Graded on the modified Davis scale
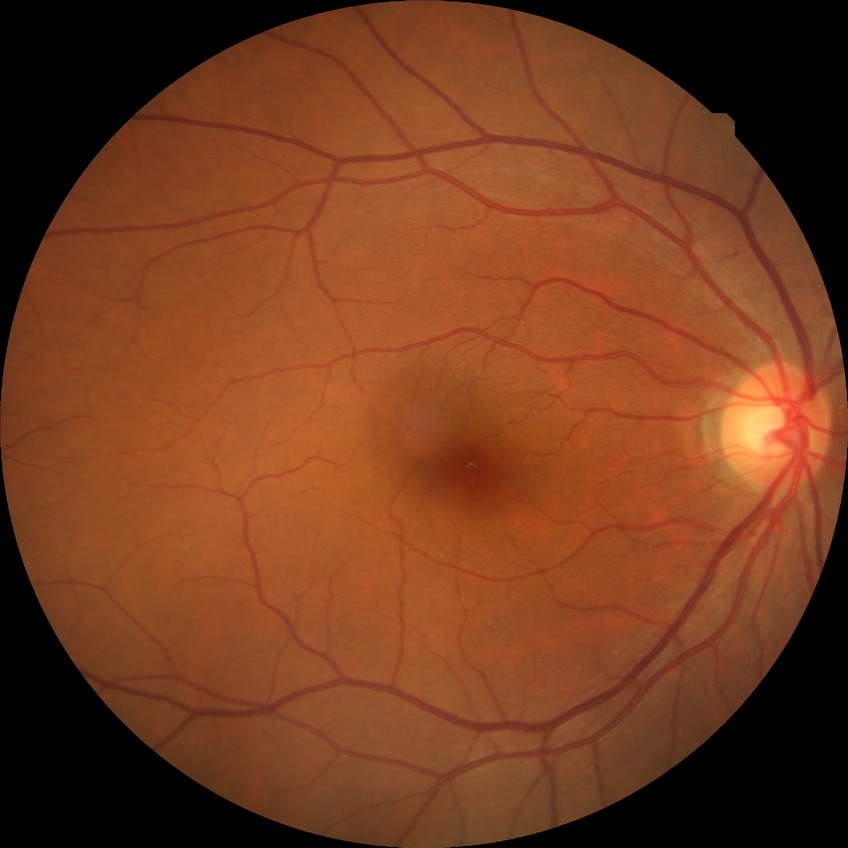
Diabetic retinopathy (DR): NDR (no diabetic retinopathy).